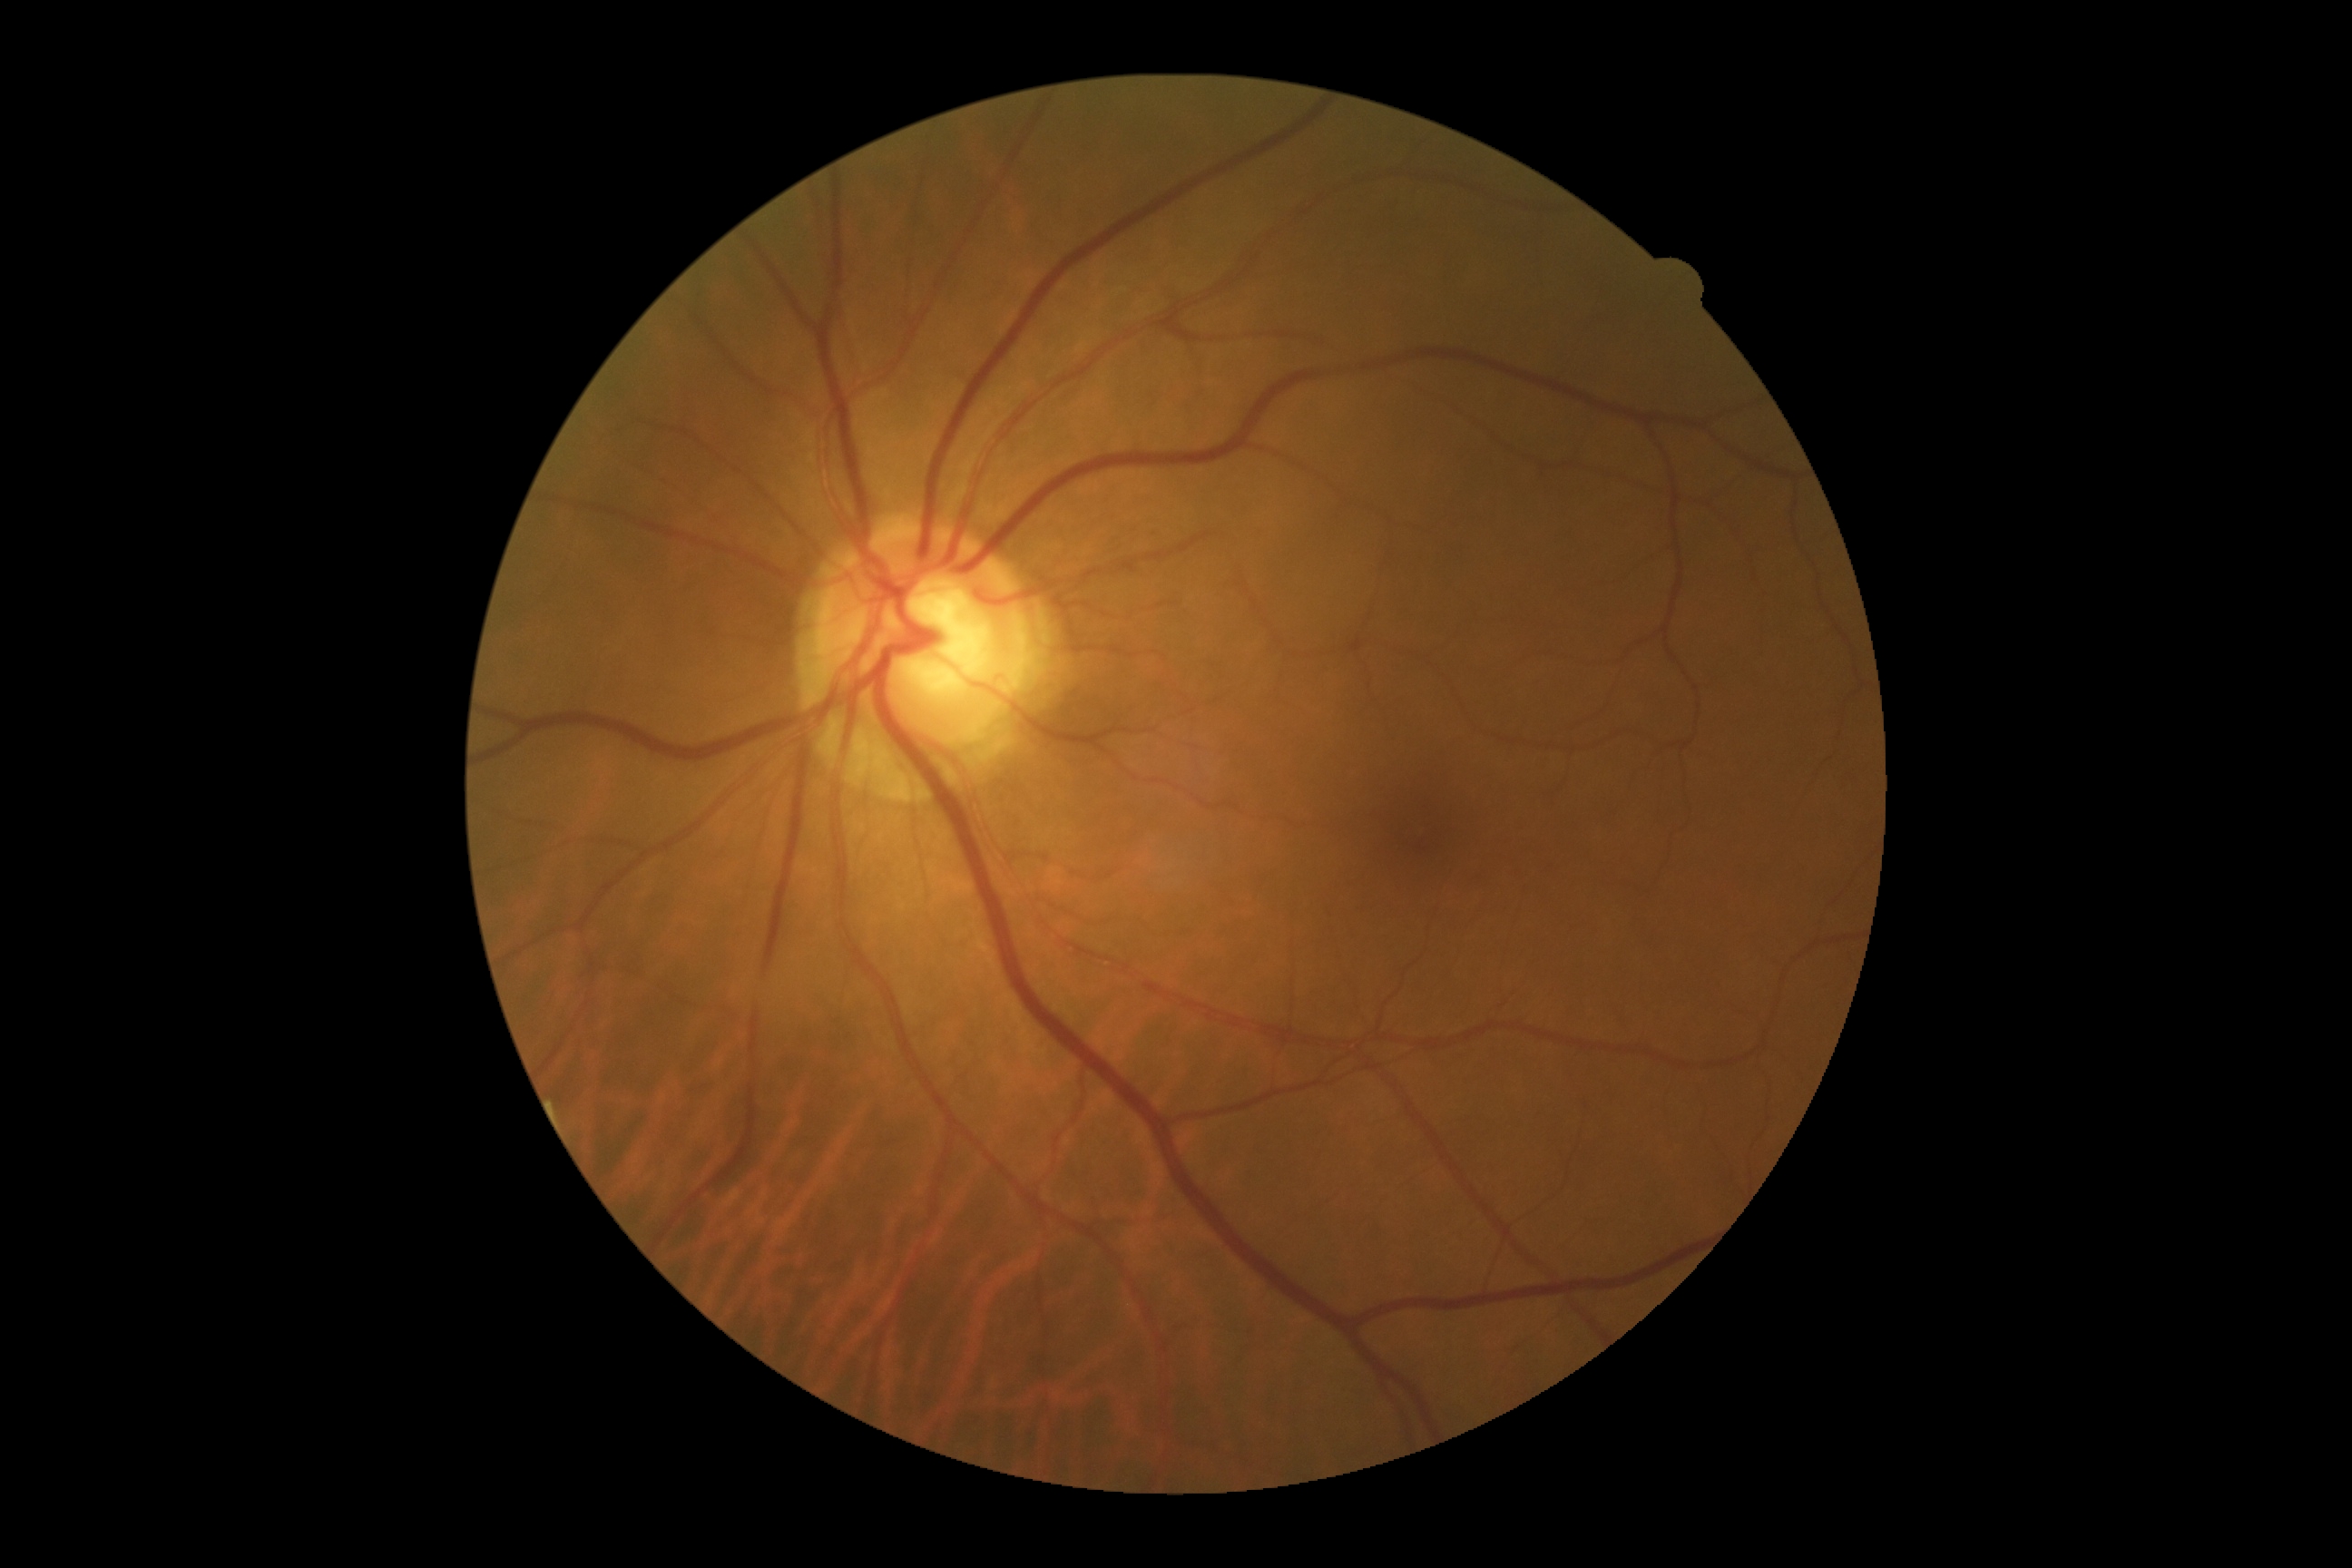
DR severity is 0/4.